NIDEK AFC-230 fundus camera; DR severity per modified Davis staging; 45° field of view:
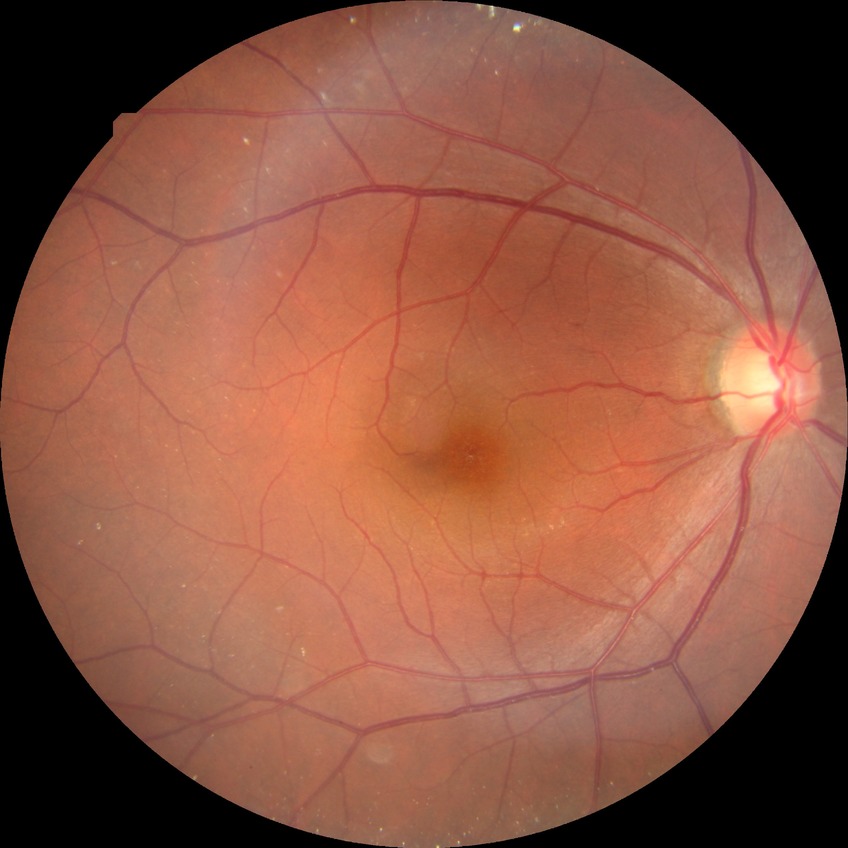

Diabetic retinopathy severity: simple diabetic retinopathy.